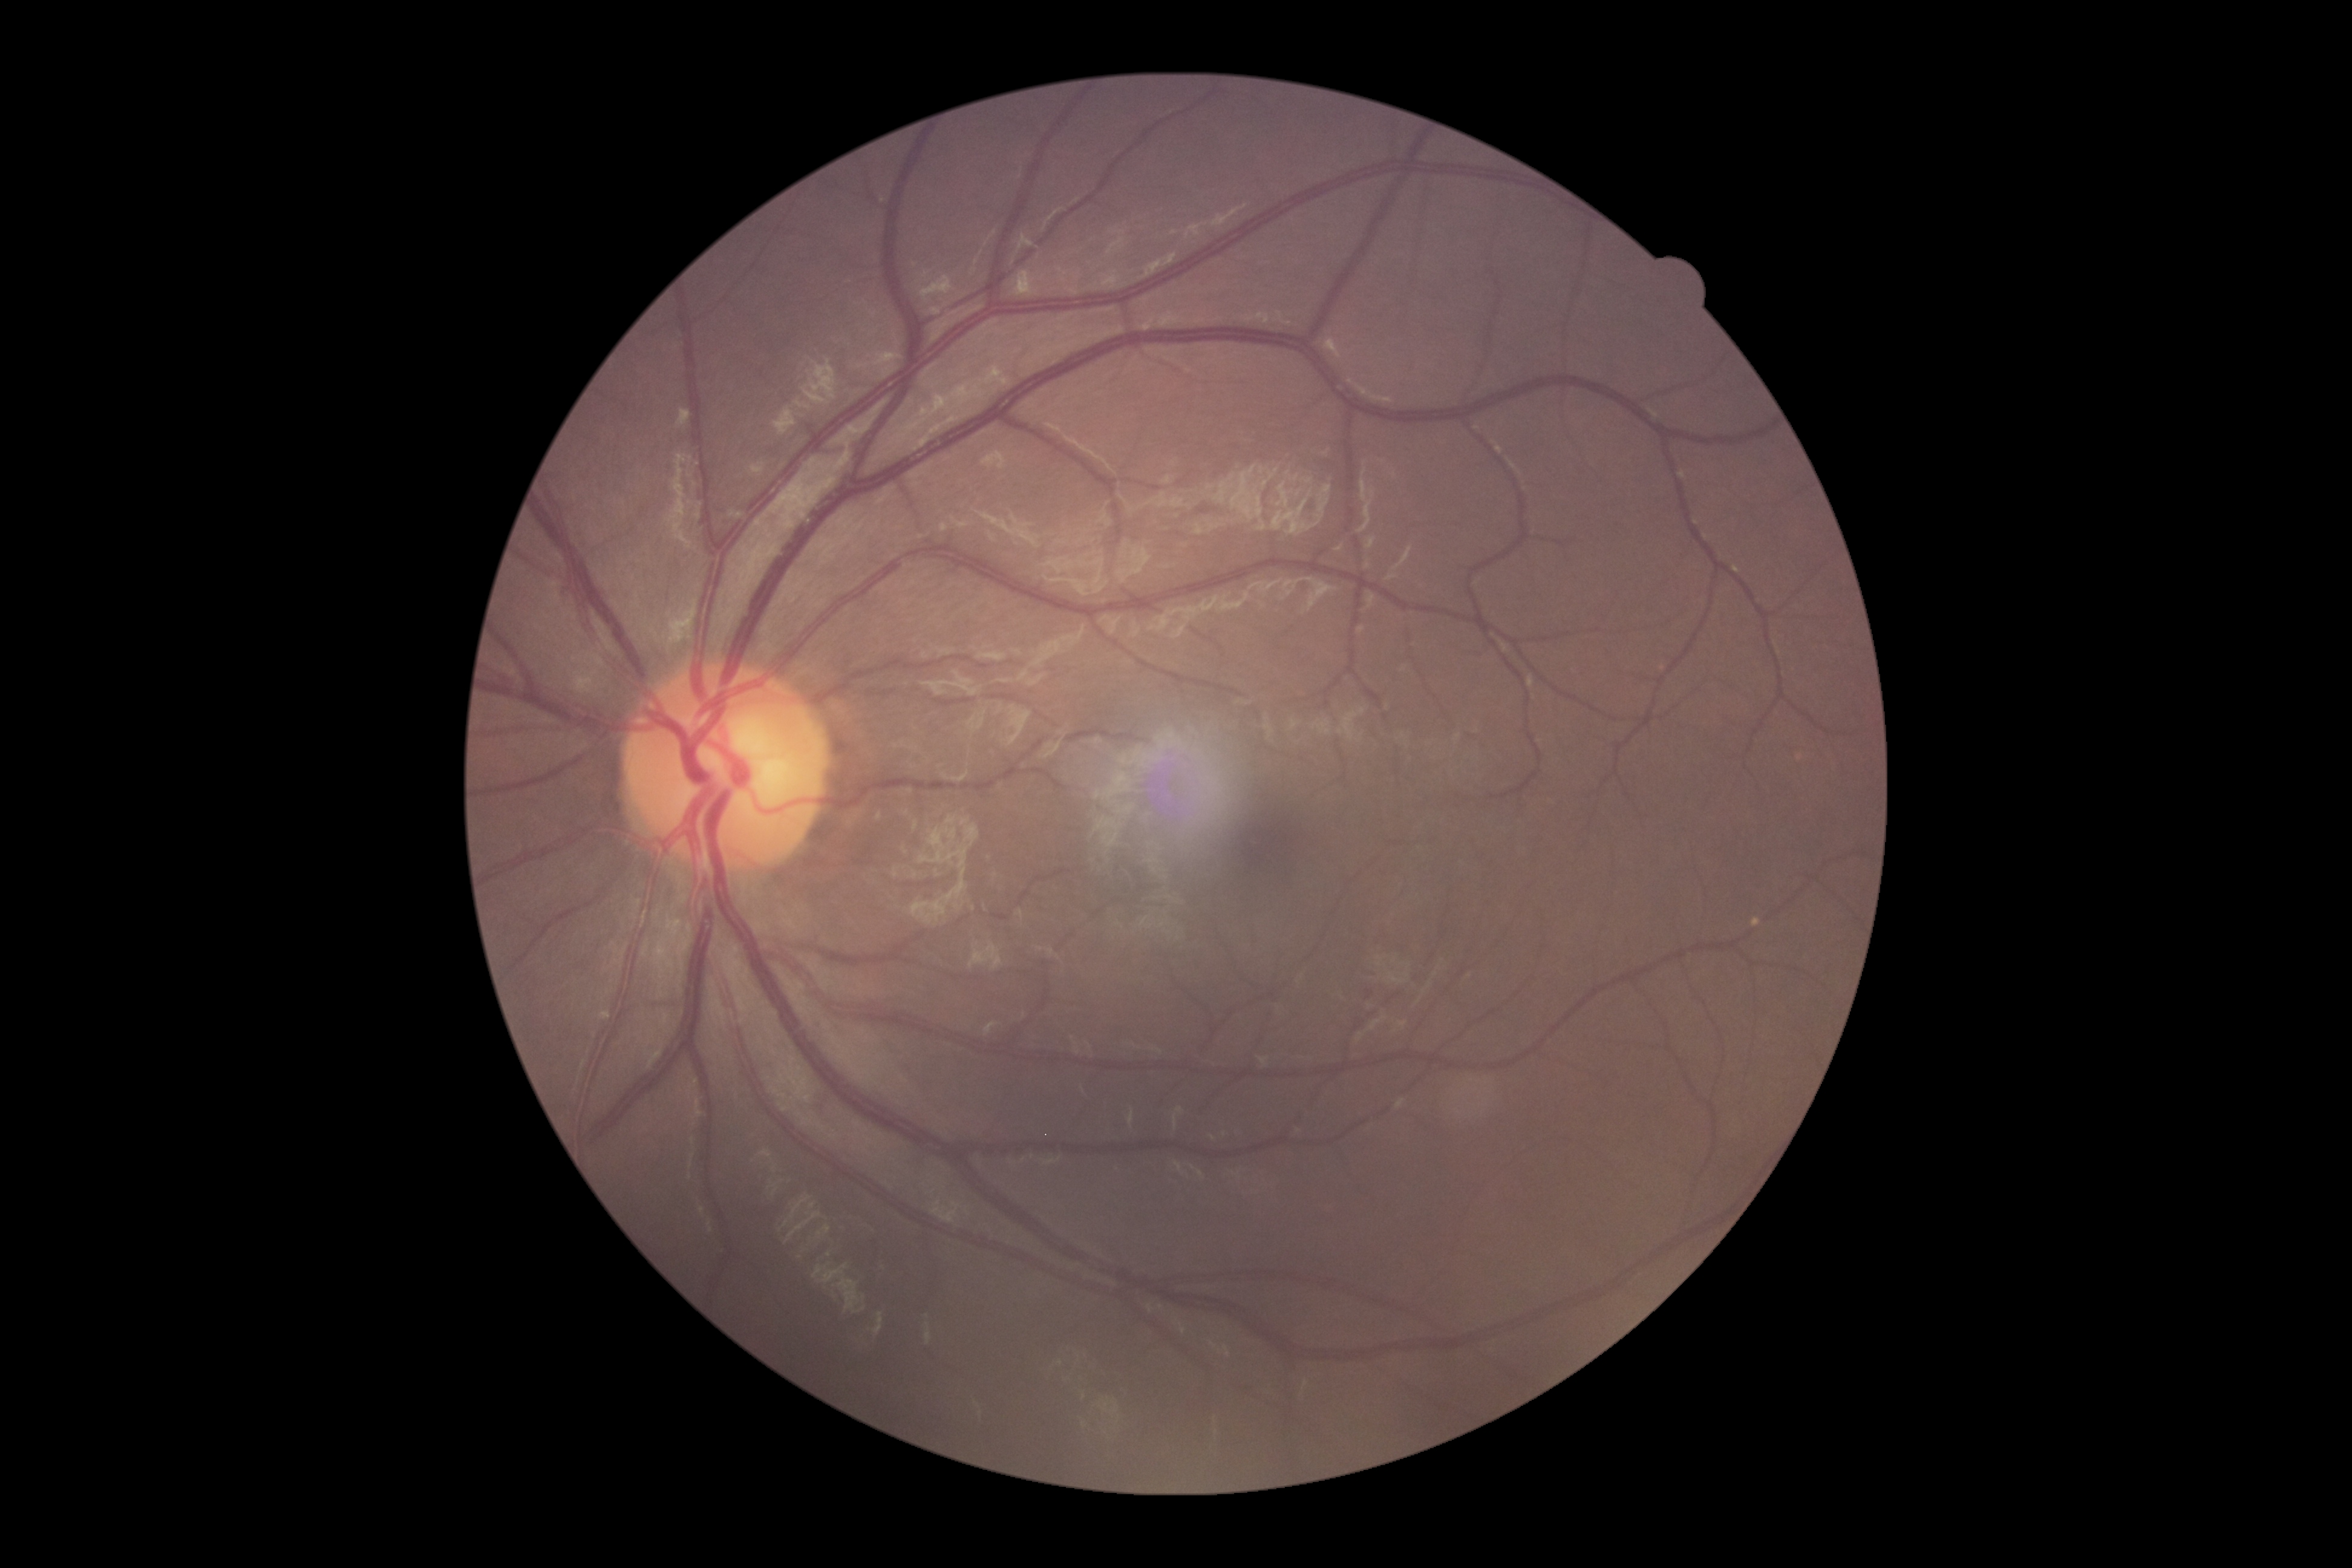

diabetic retinopathy = no apparent diabetic retinopathy (grade 0).